2352 by 1568 pixels, retinal fundus photograph, 45-degree field of view — 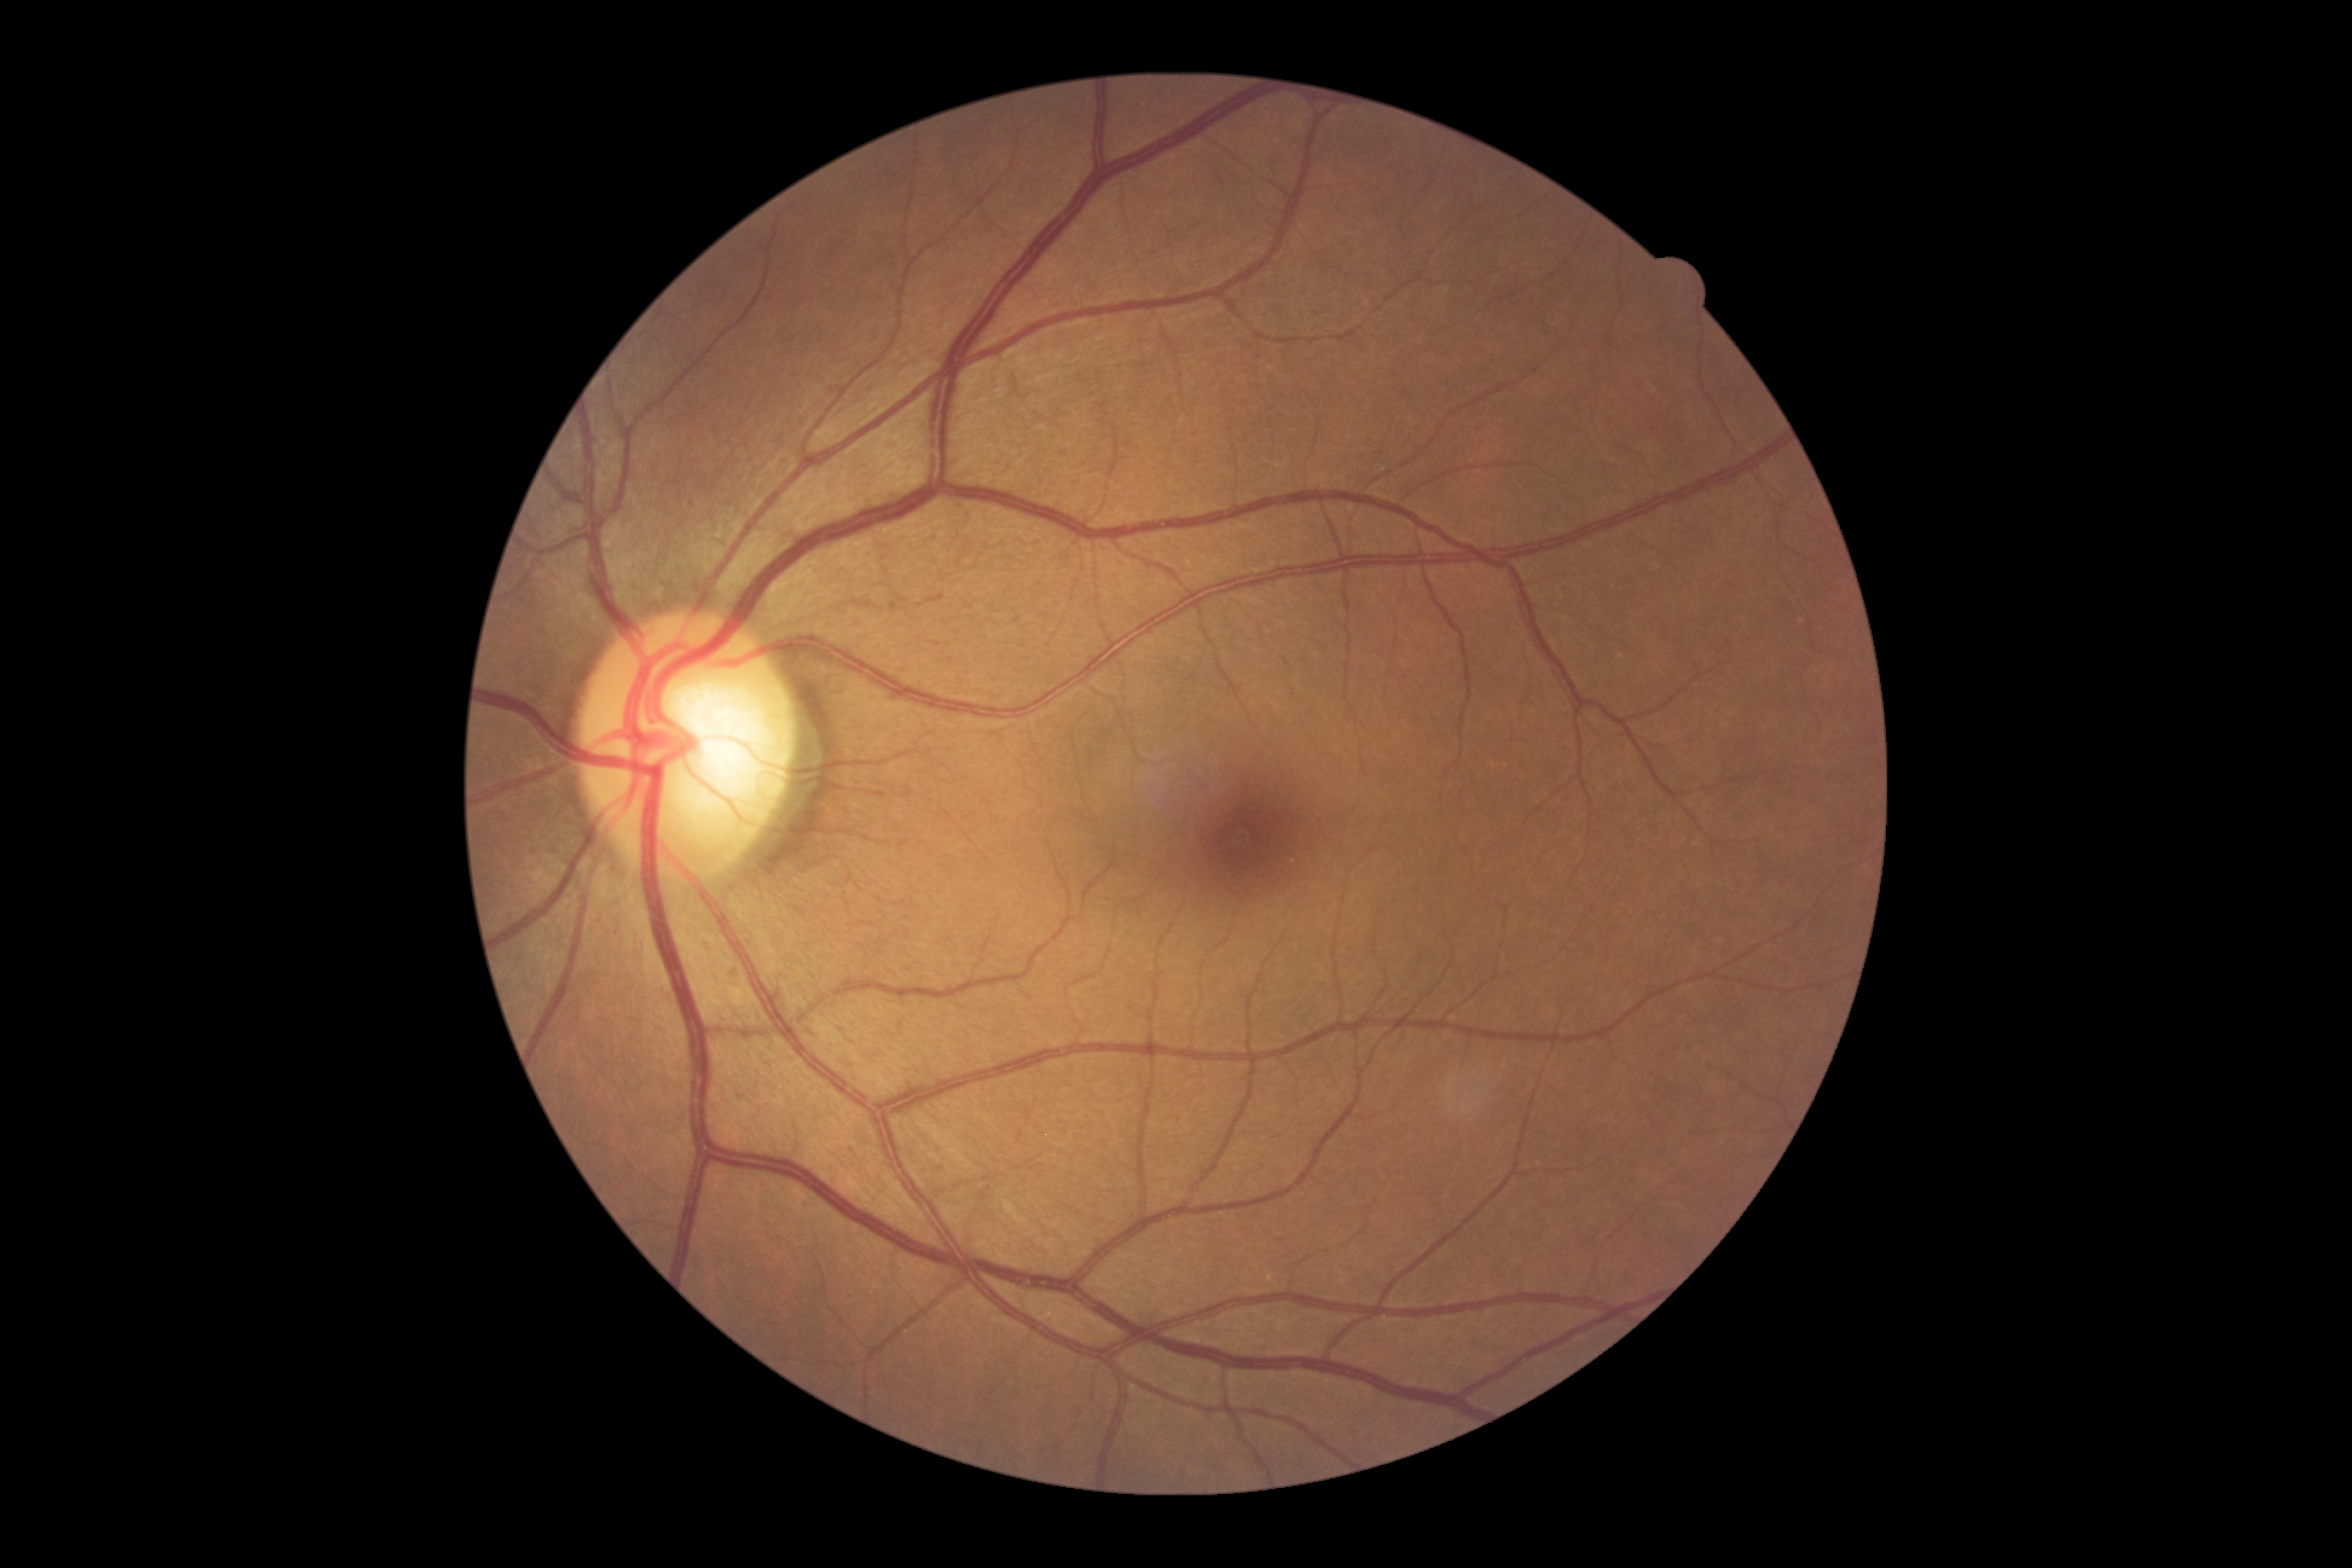

DR severity=grade 0.